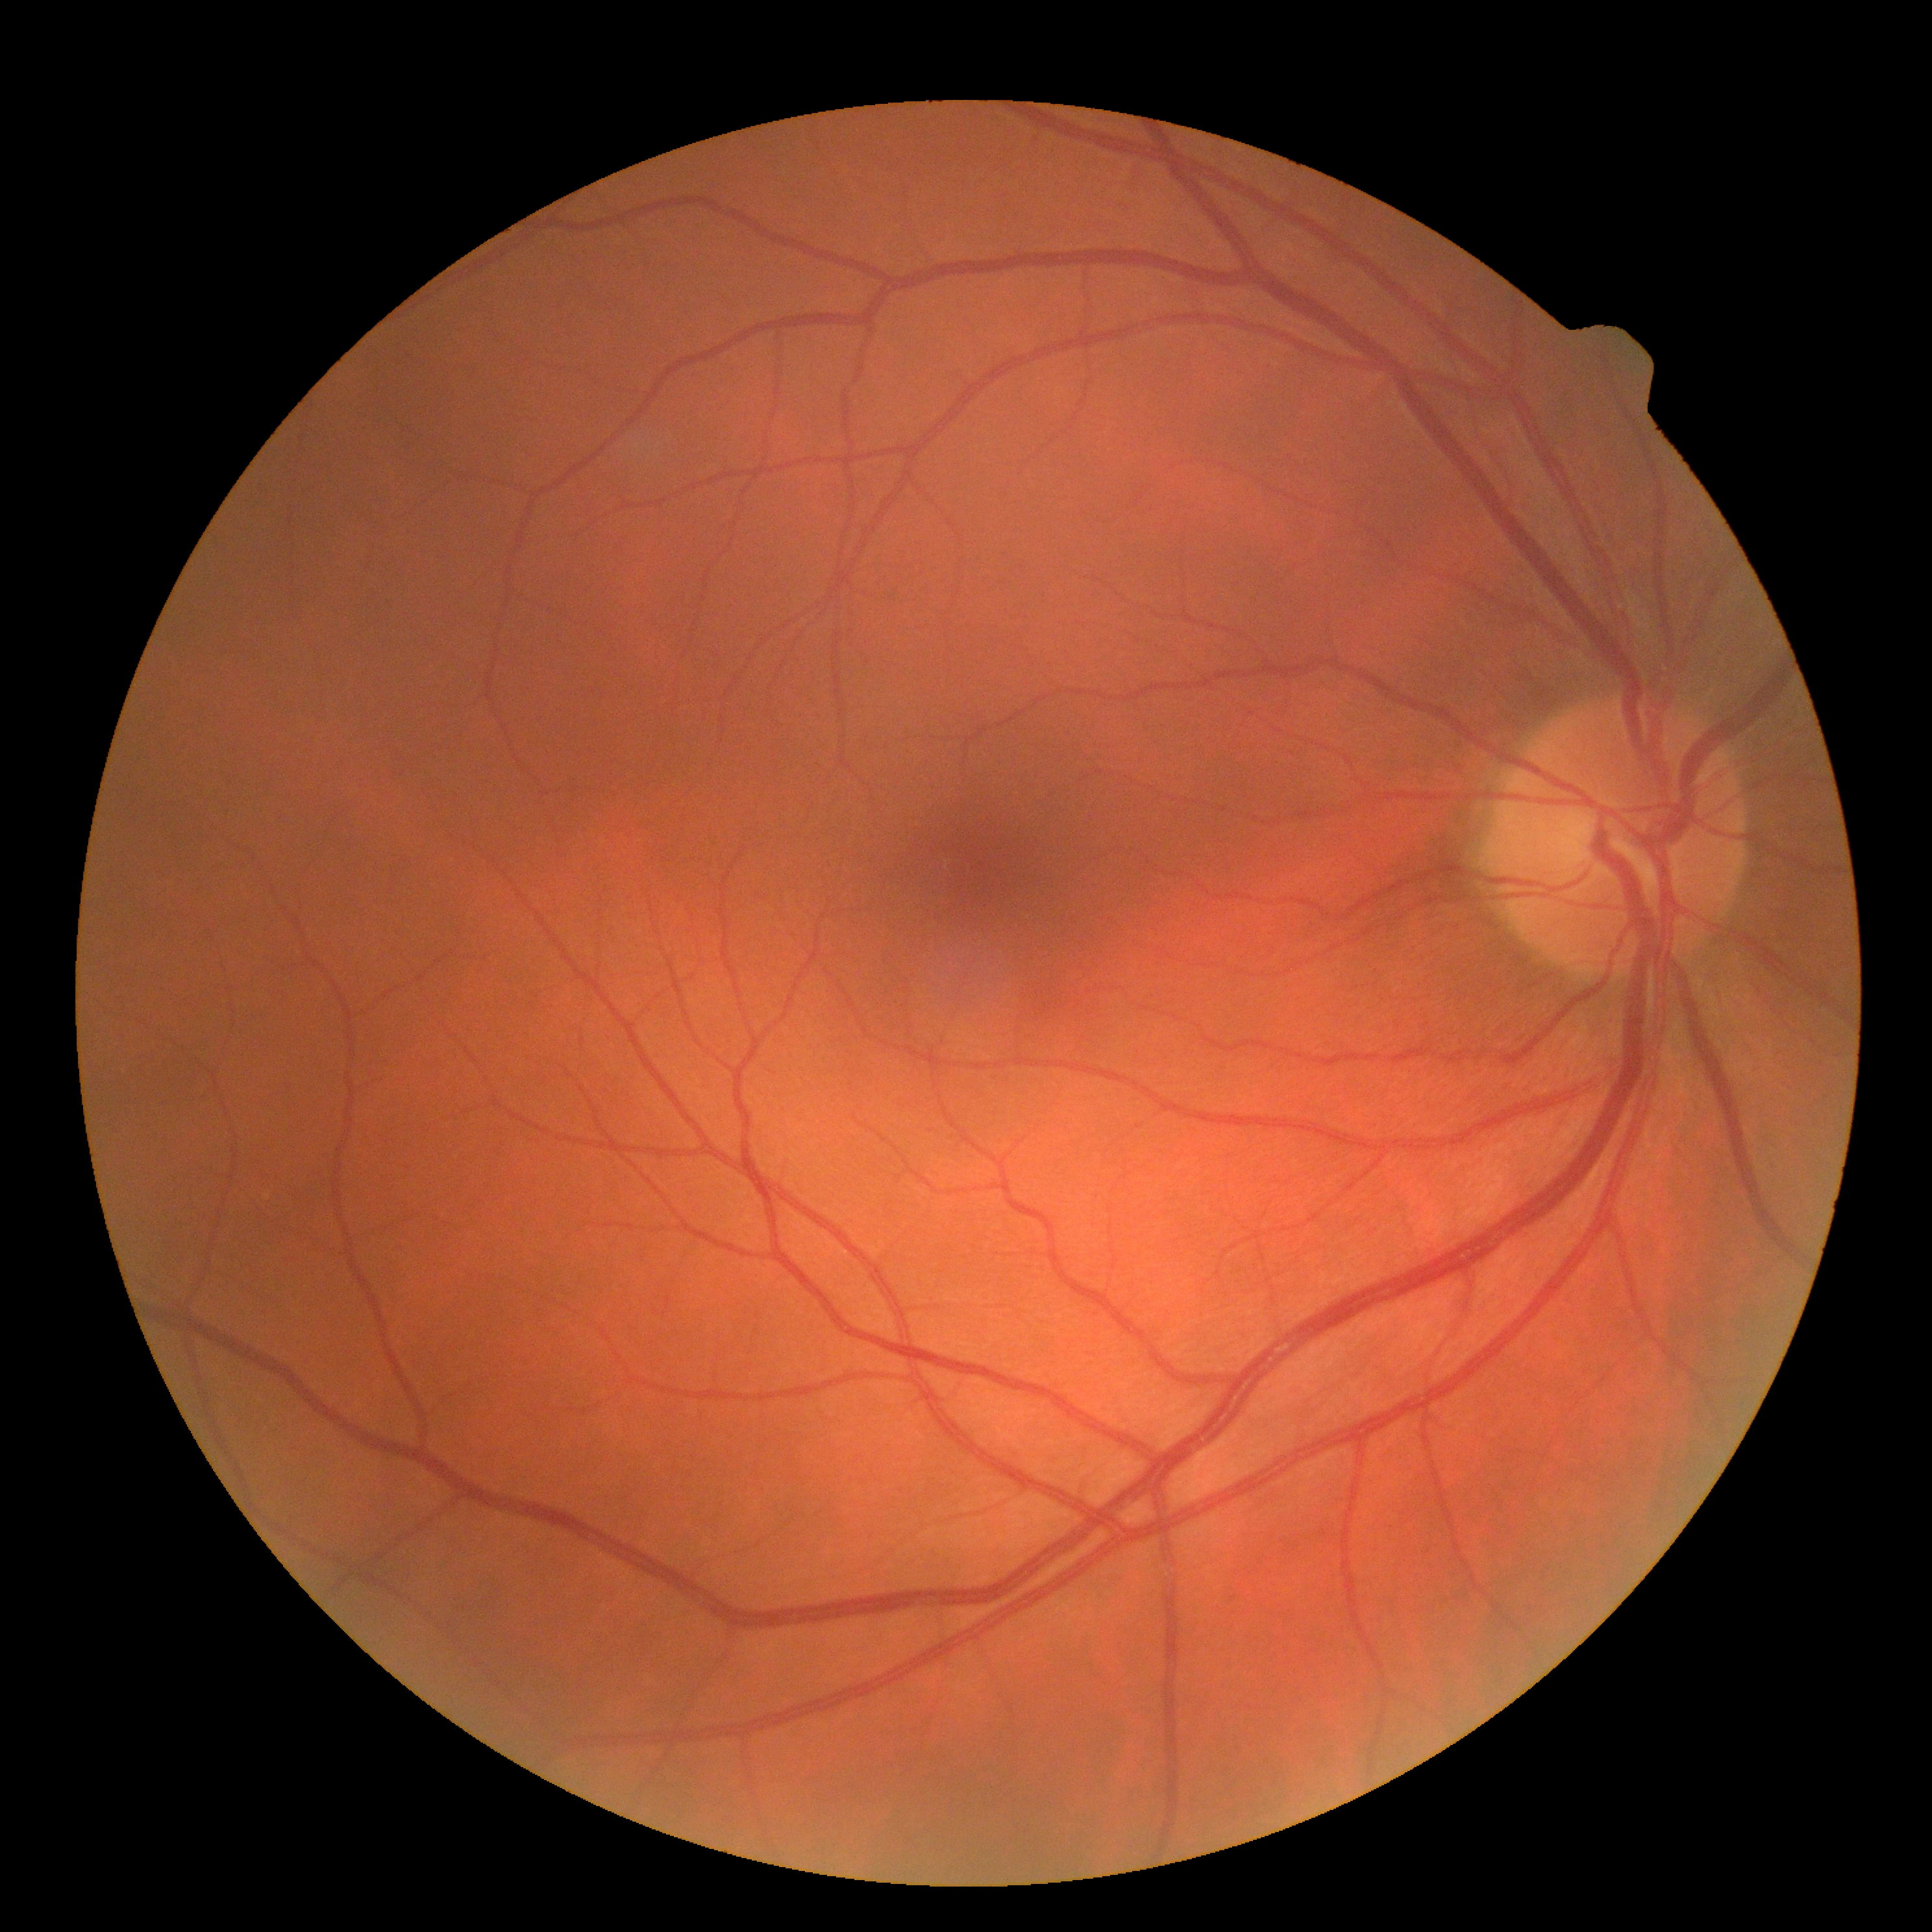

DR: 0 — no visible signs of diabetic retinopathy.